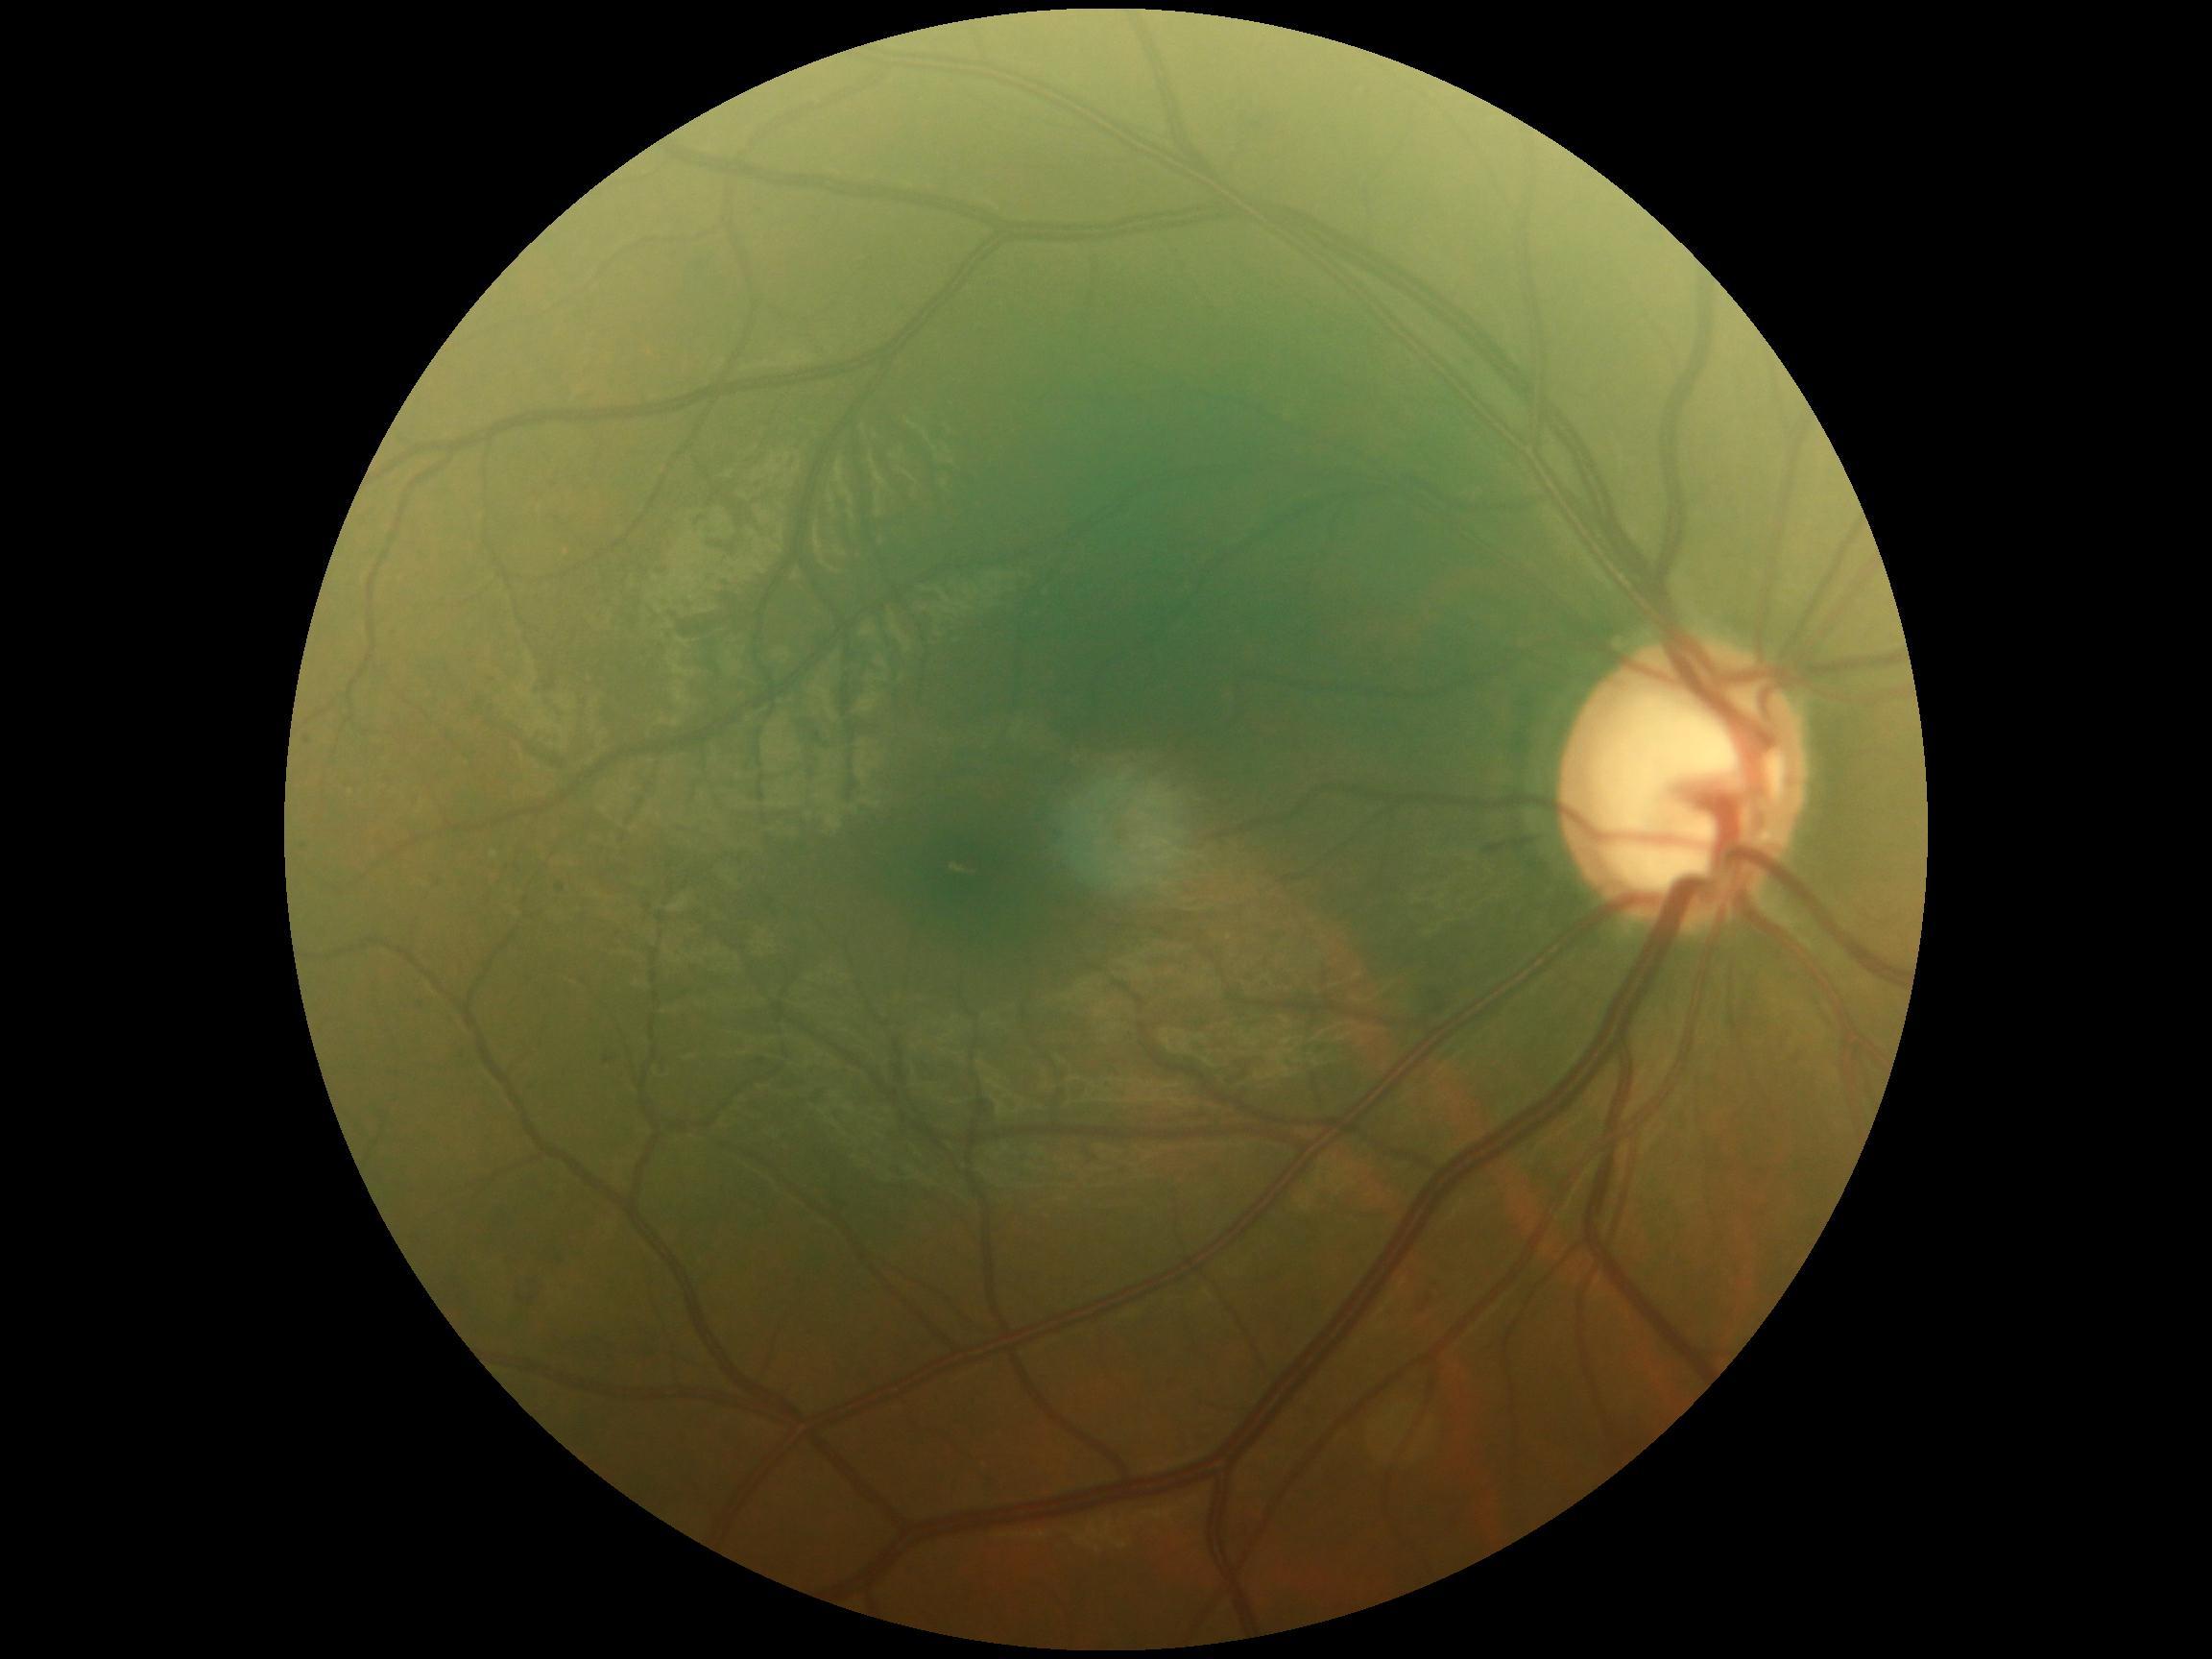 Diabetic retinopathy (DR): moderate NPDR (grade 2).